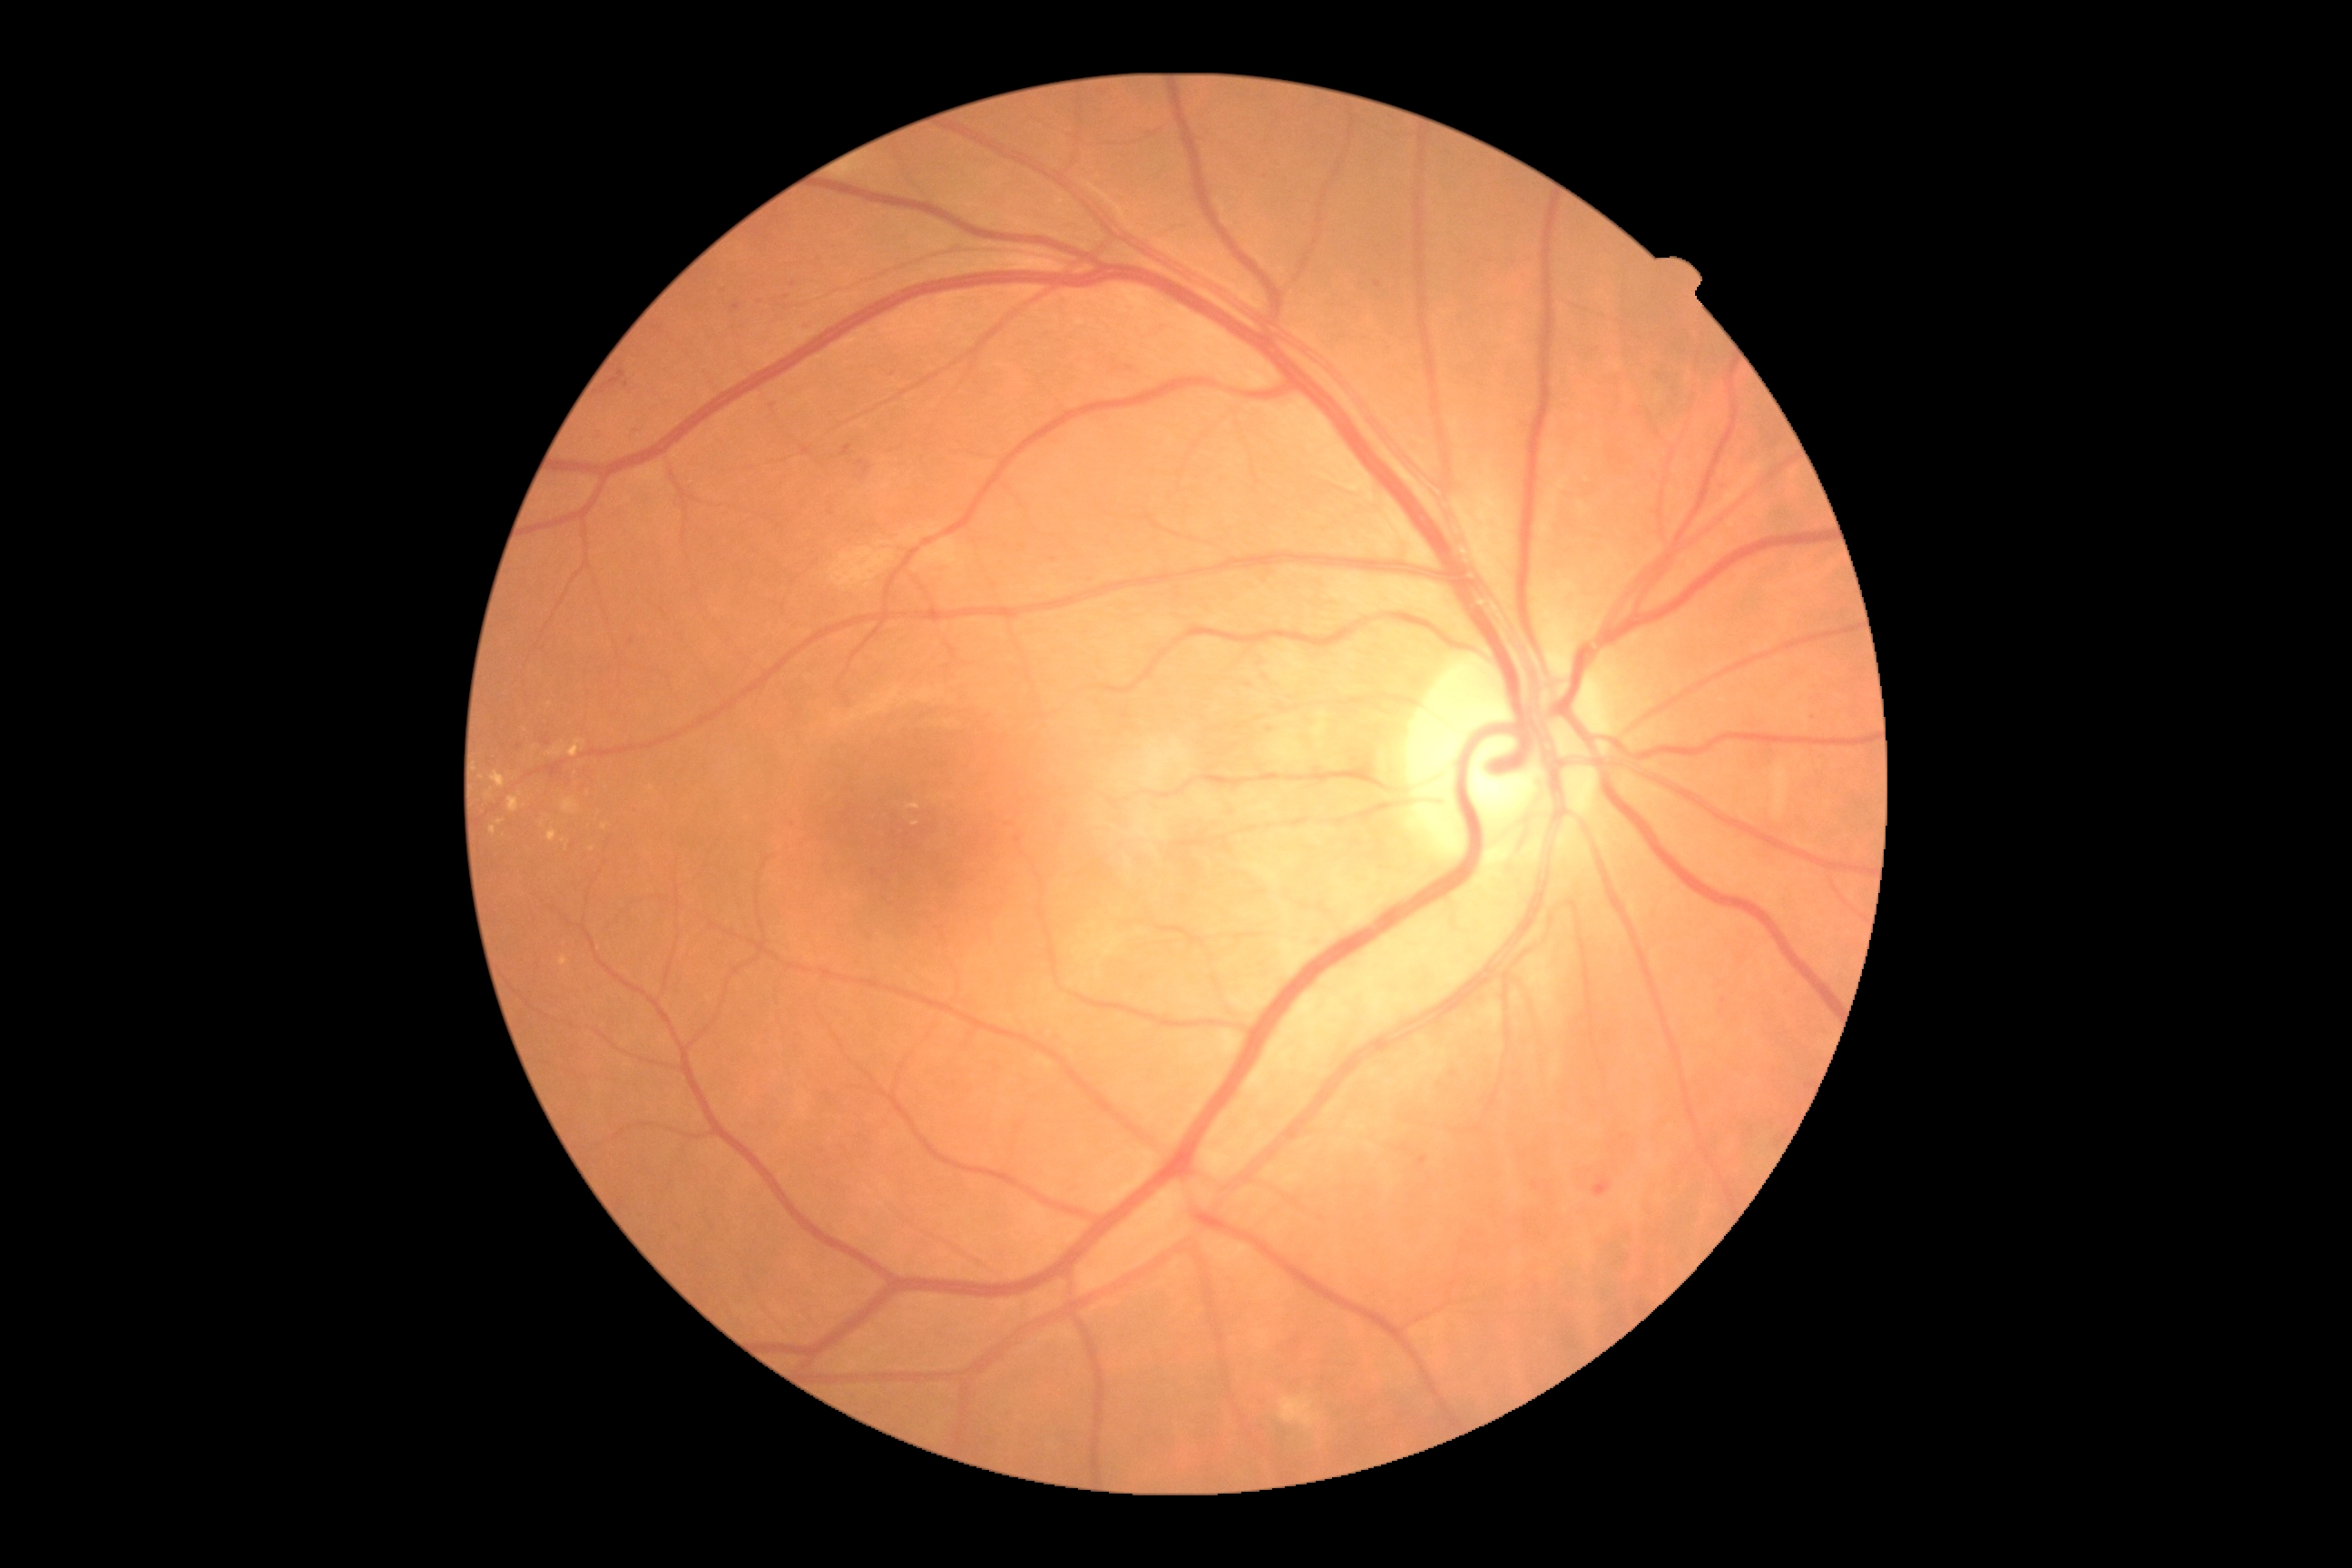
Annotations:
• DR class — non-proliferative diabetic retinopathy
• diabetic retinopathy (DR) — grade 2 (moderate NPDR)